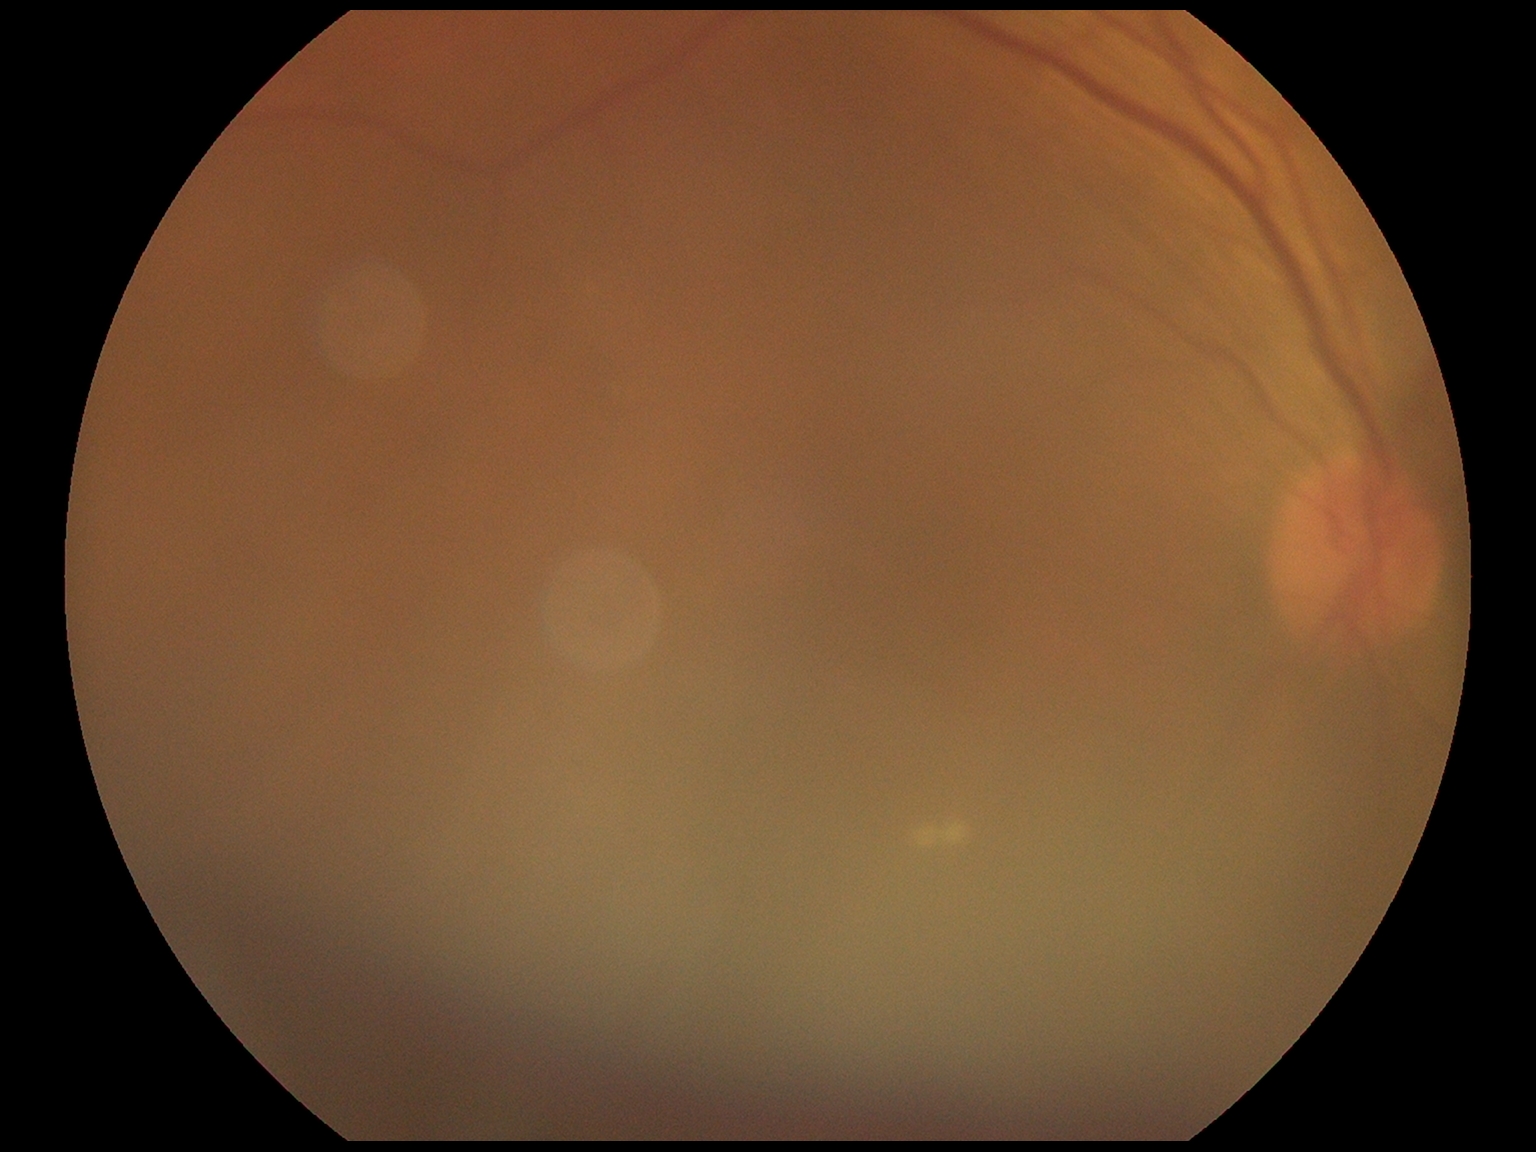
DR grade is ungradable due to poor image quality.
The image cannot be graded for diabetic retinopathy.